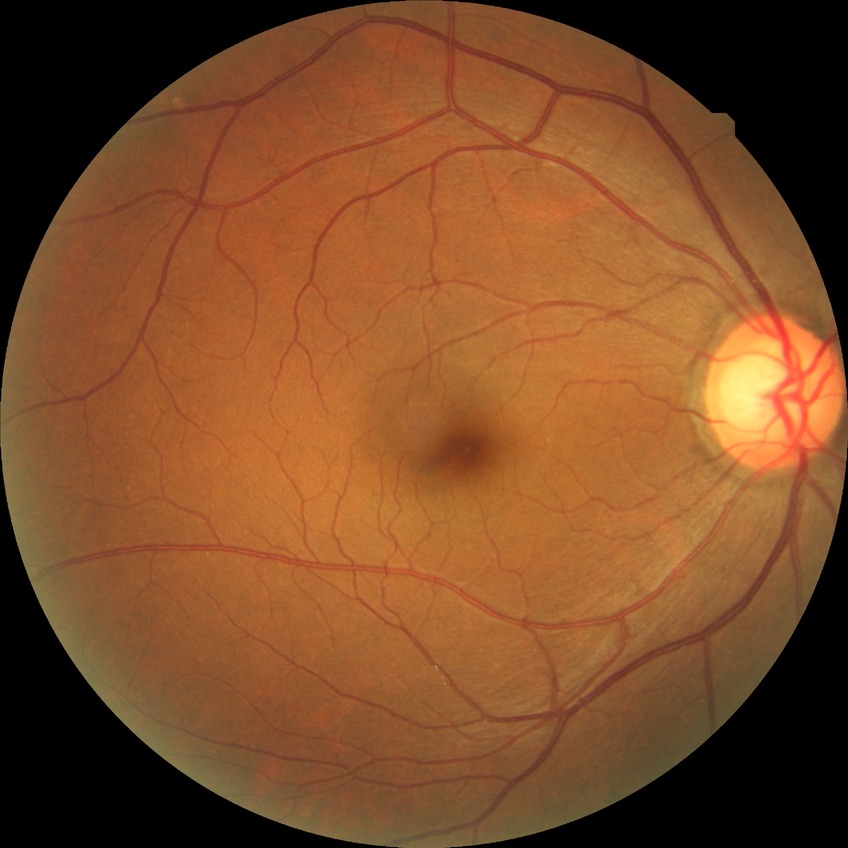

diabetic retinopathy (DR)=no diabetic retinopathy (NDR).